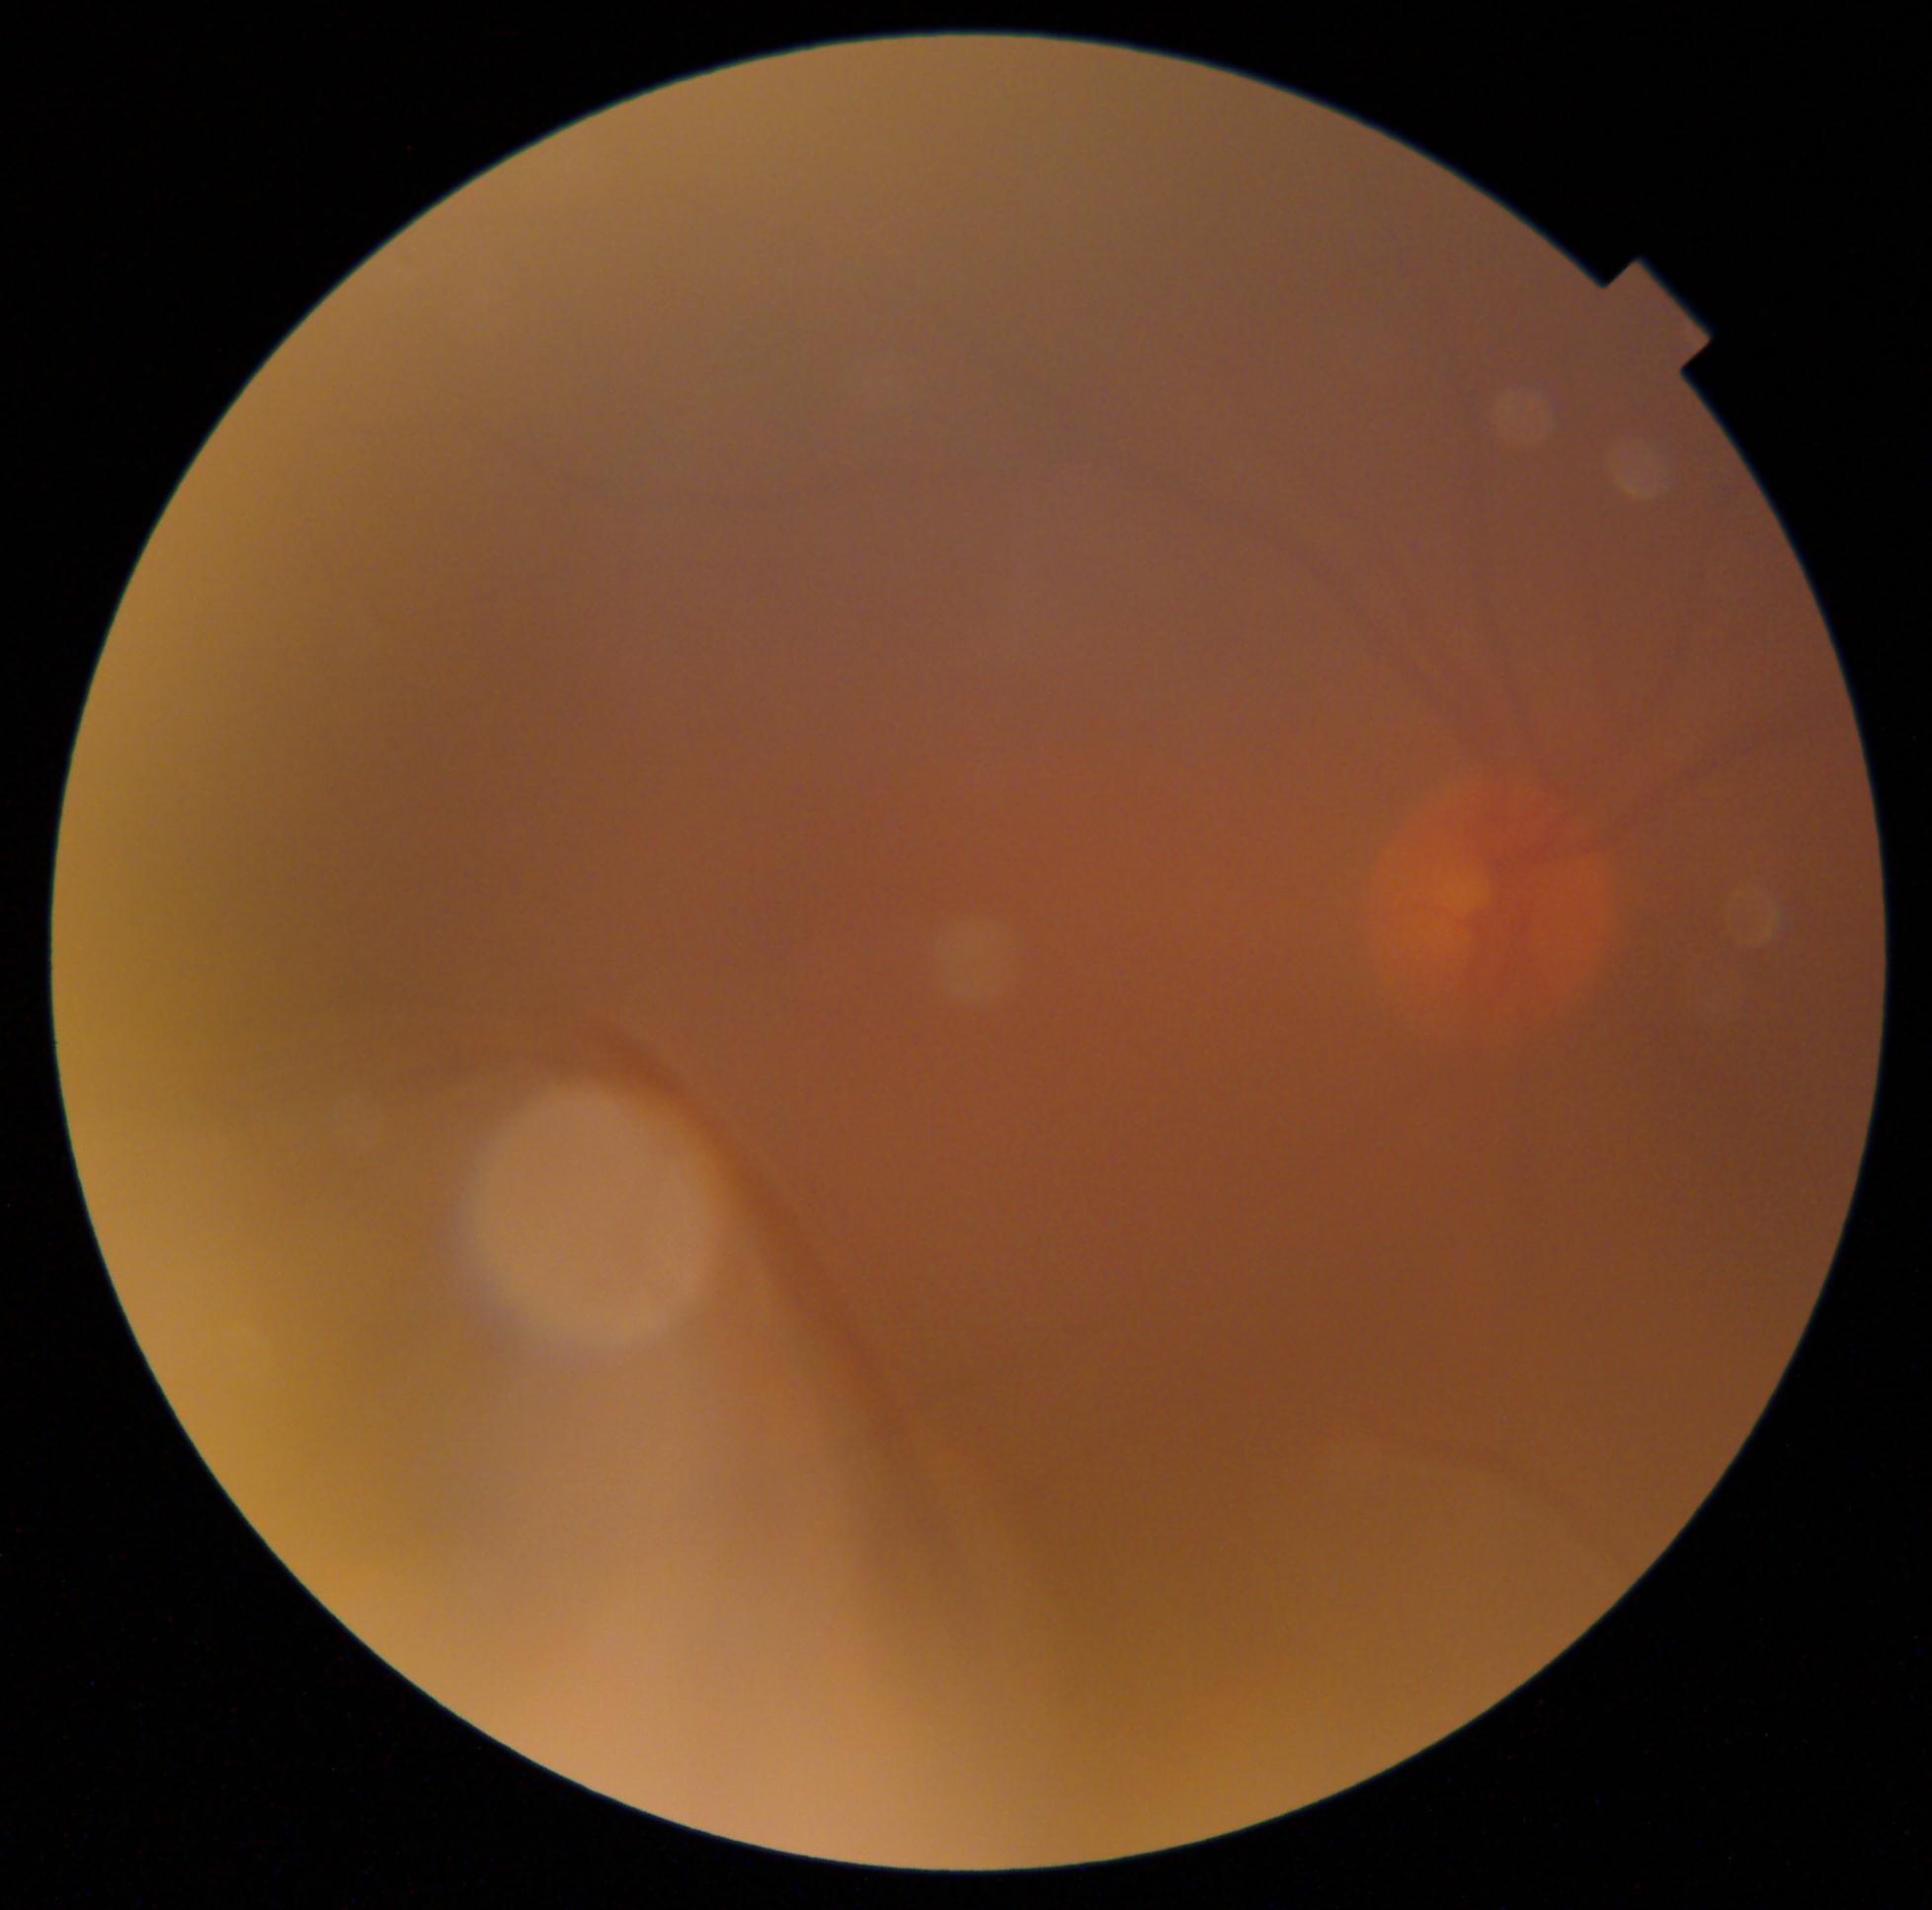

Findings:
- DR severity — ungradable due to poor image quality
- image quality — insufficient for DR assessment